45° field of view. 2184 by 1690 pixels. Color fundus image.
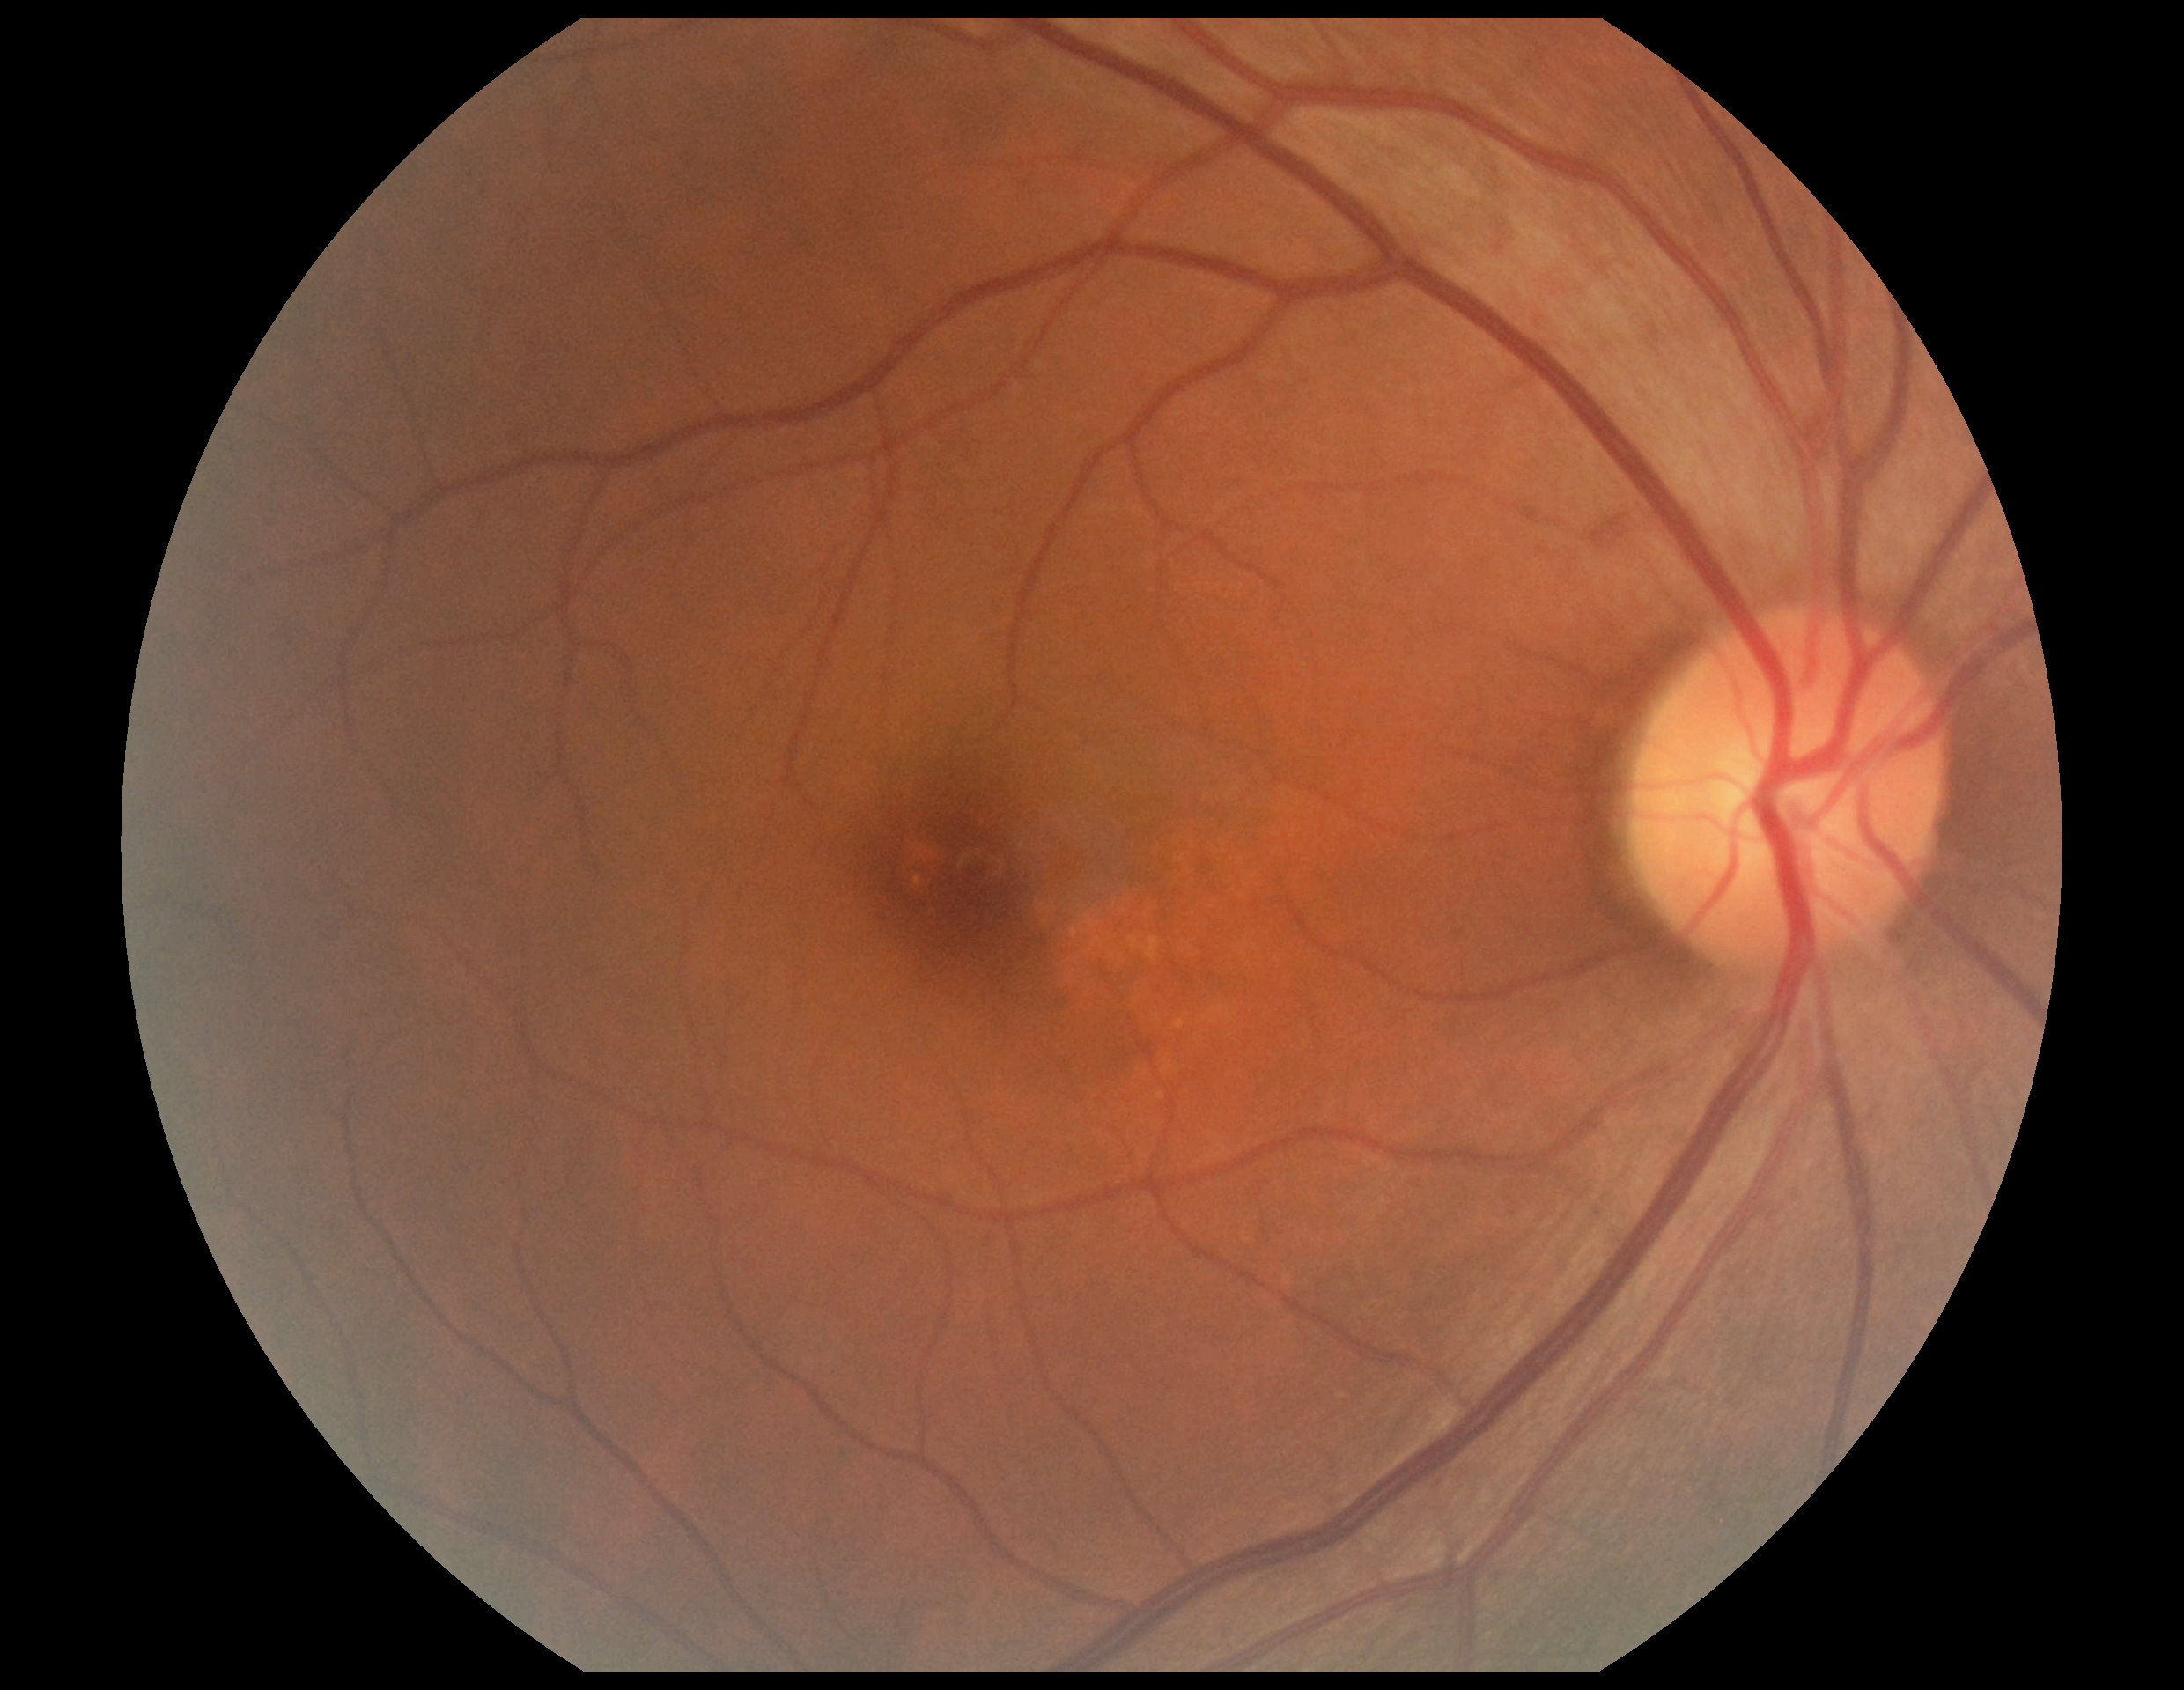

Diabetic retinopathy grade: 0 (no apparent retinopathy).